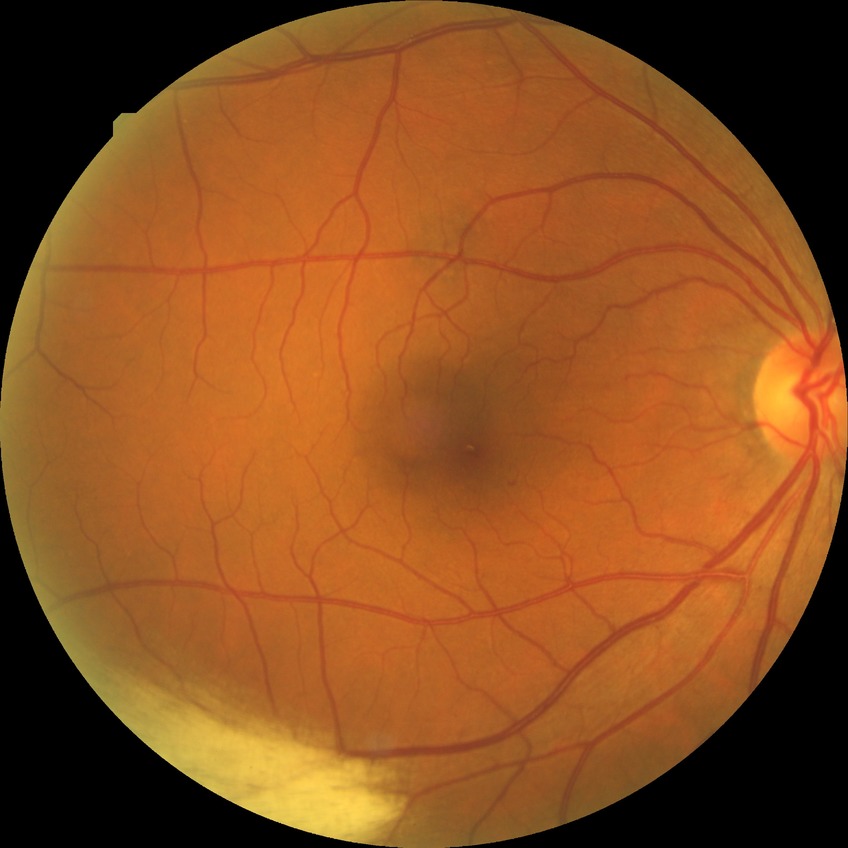
DR stage is NDR.